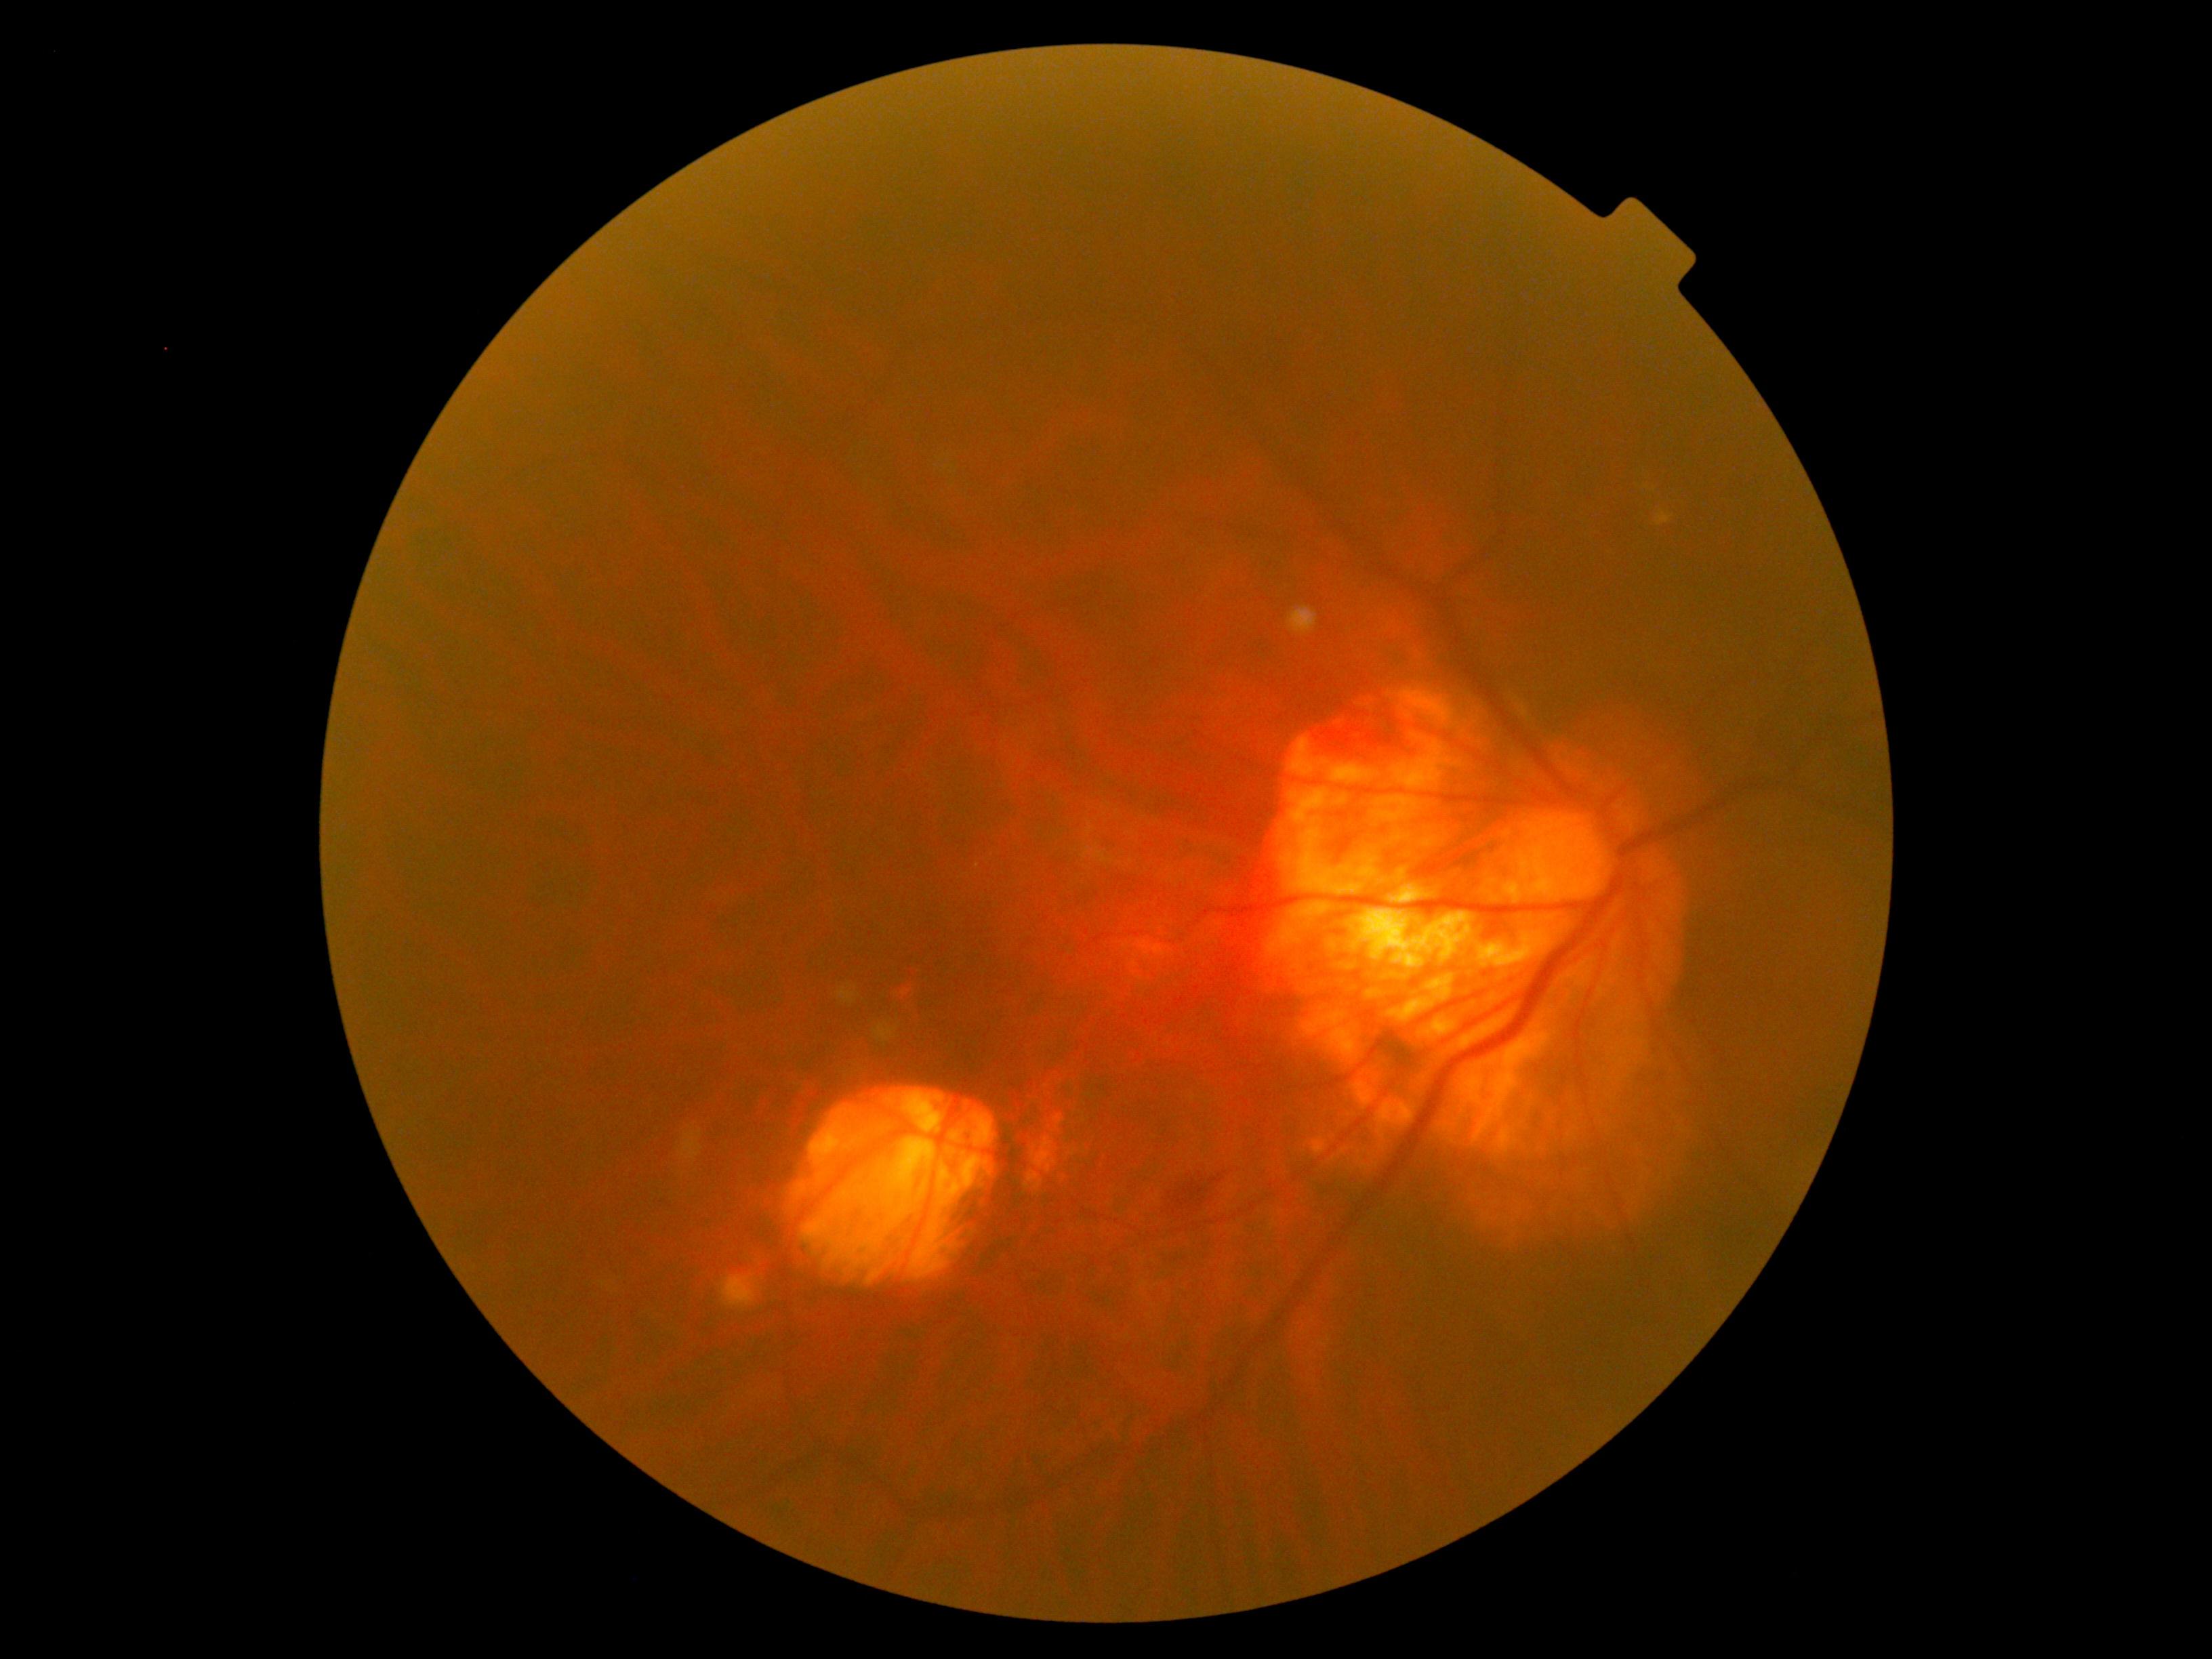
DR stage is moderate NPDR (grade 2).
DR class: non-proliferative diabetic retinopathy.